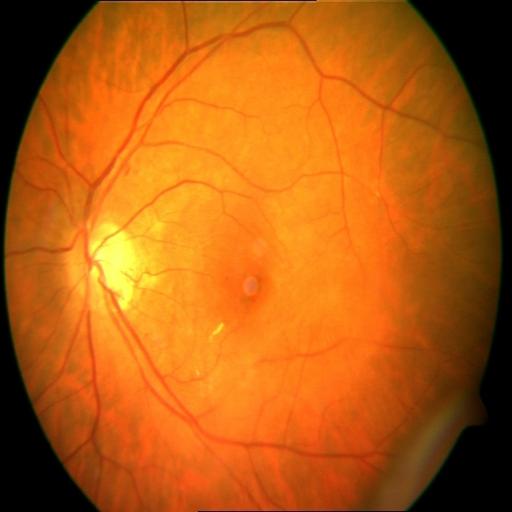

3 abnormalities. Findings consistent with myopia, optic disc cupping & tessellation.